Diabetic retinopathy graded by the modified Davis classification · 45° FOV: 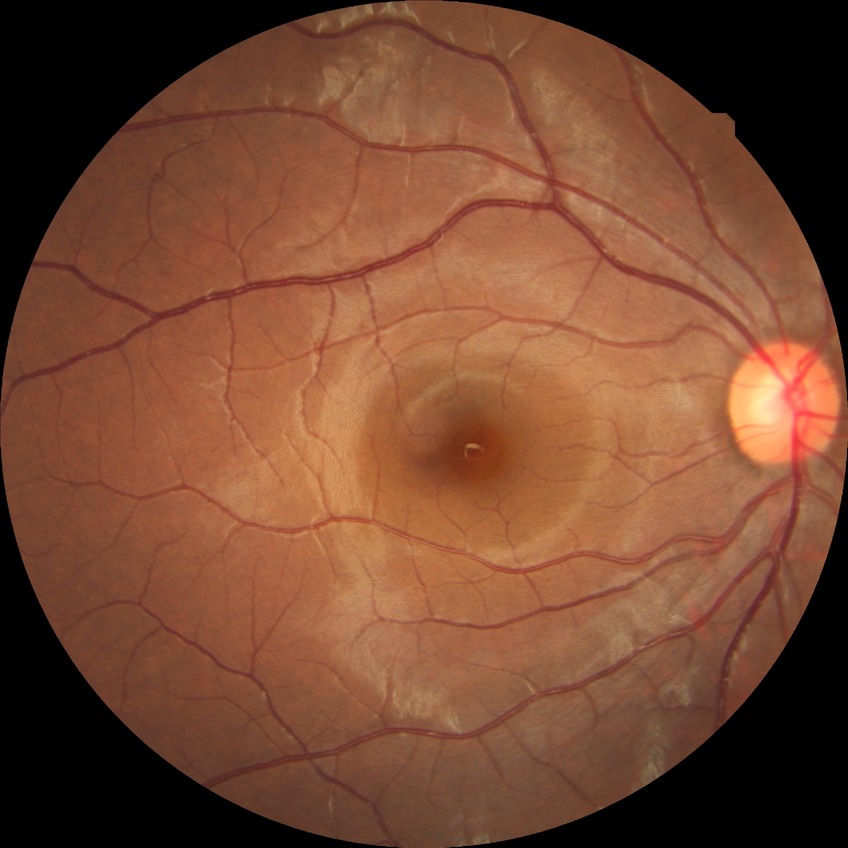 Davis DR grade@NDR.